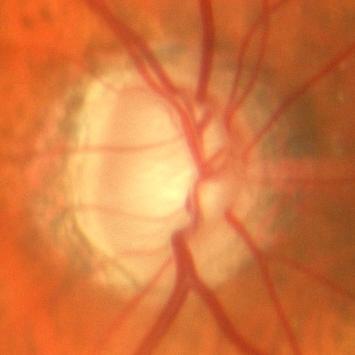

ONH-centered fundus image showing no evidence of glaucoma.